Camera: NIDEK AFC-230: 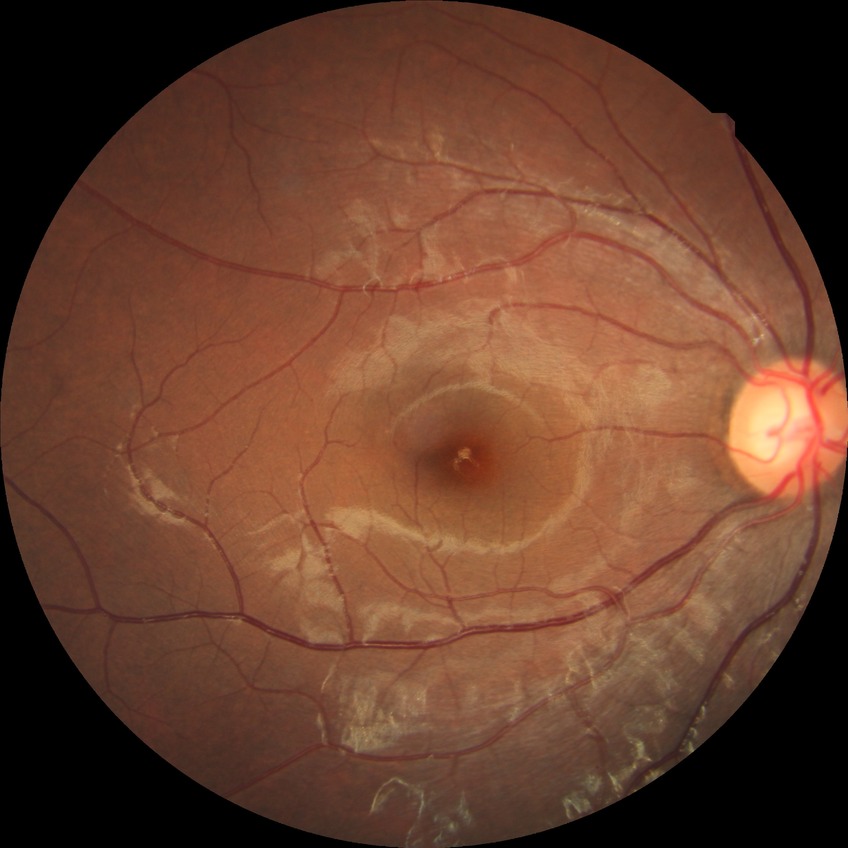
Diabetic retinopathy grade is no diabetic retinopathy.